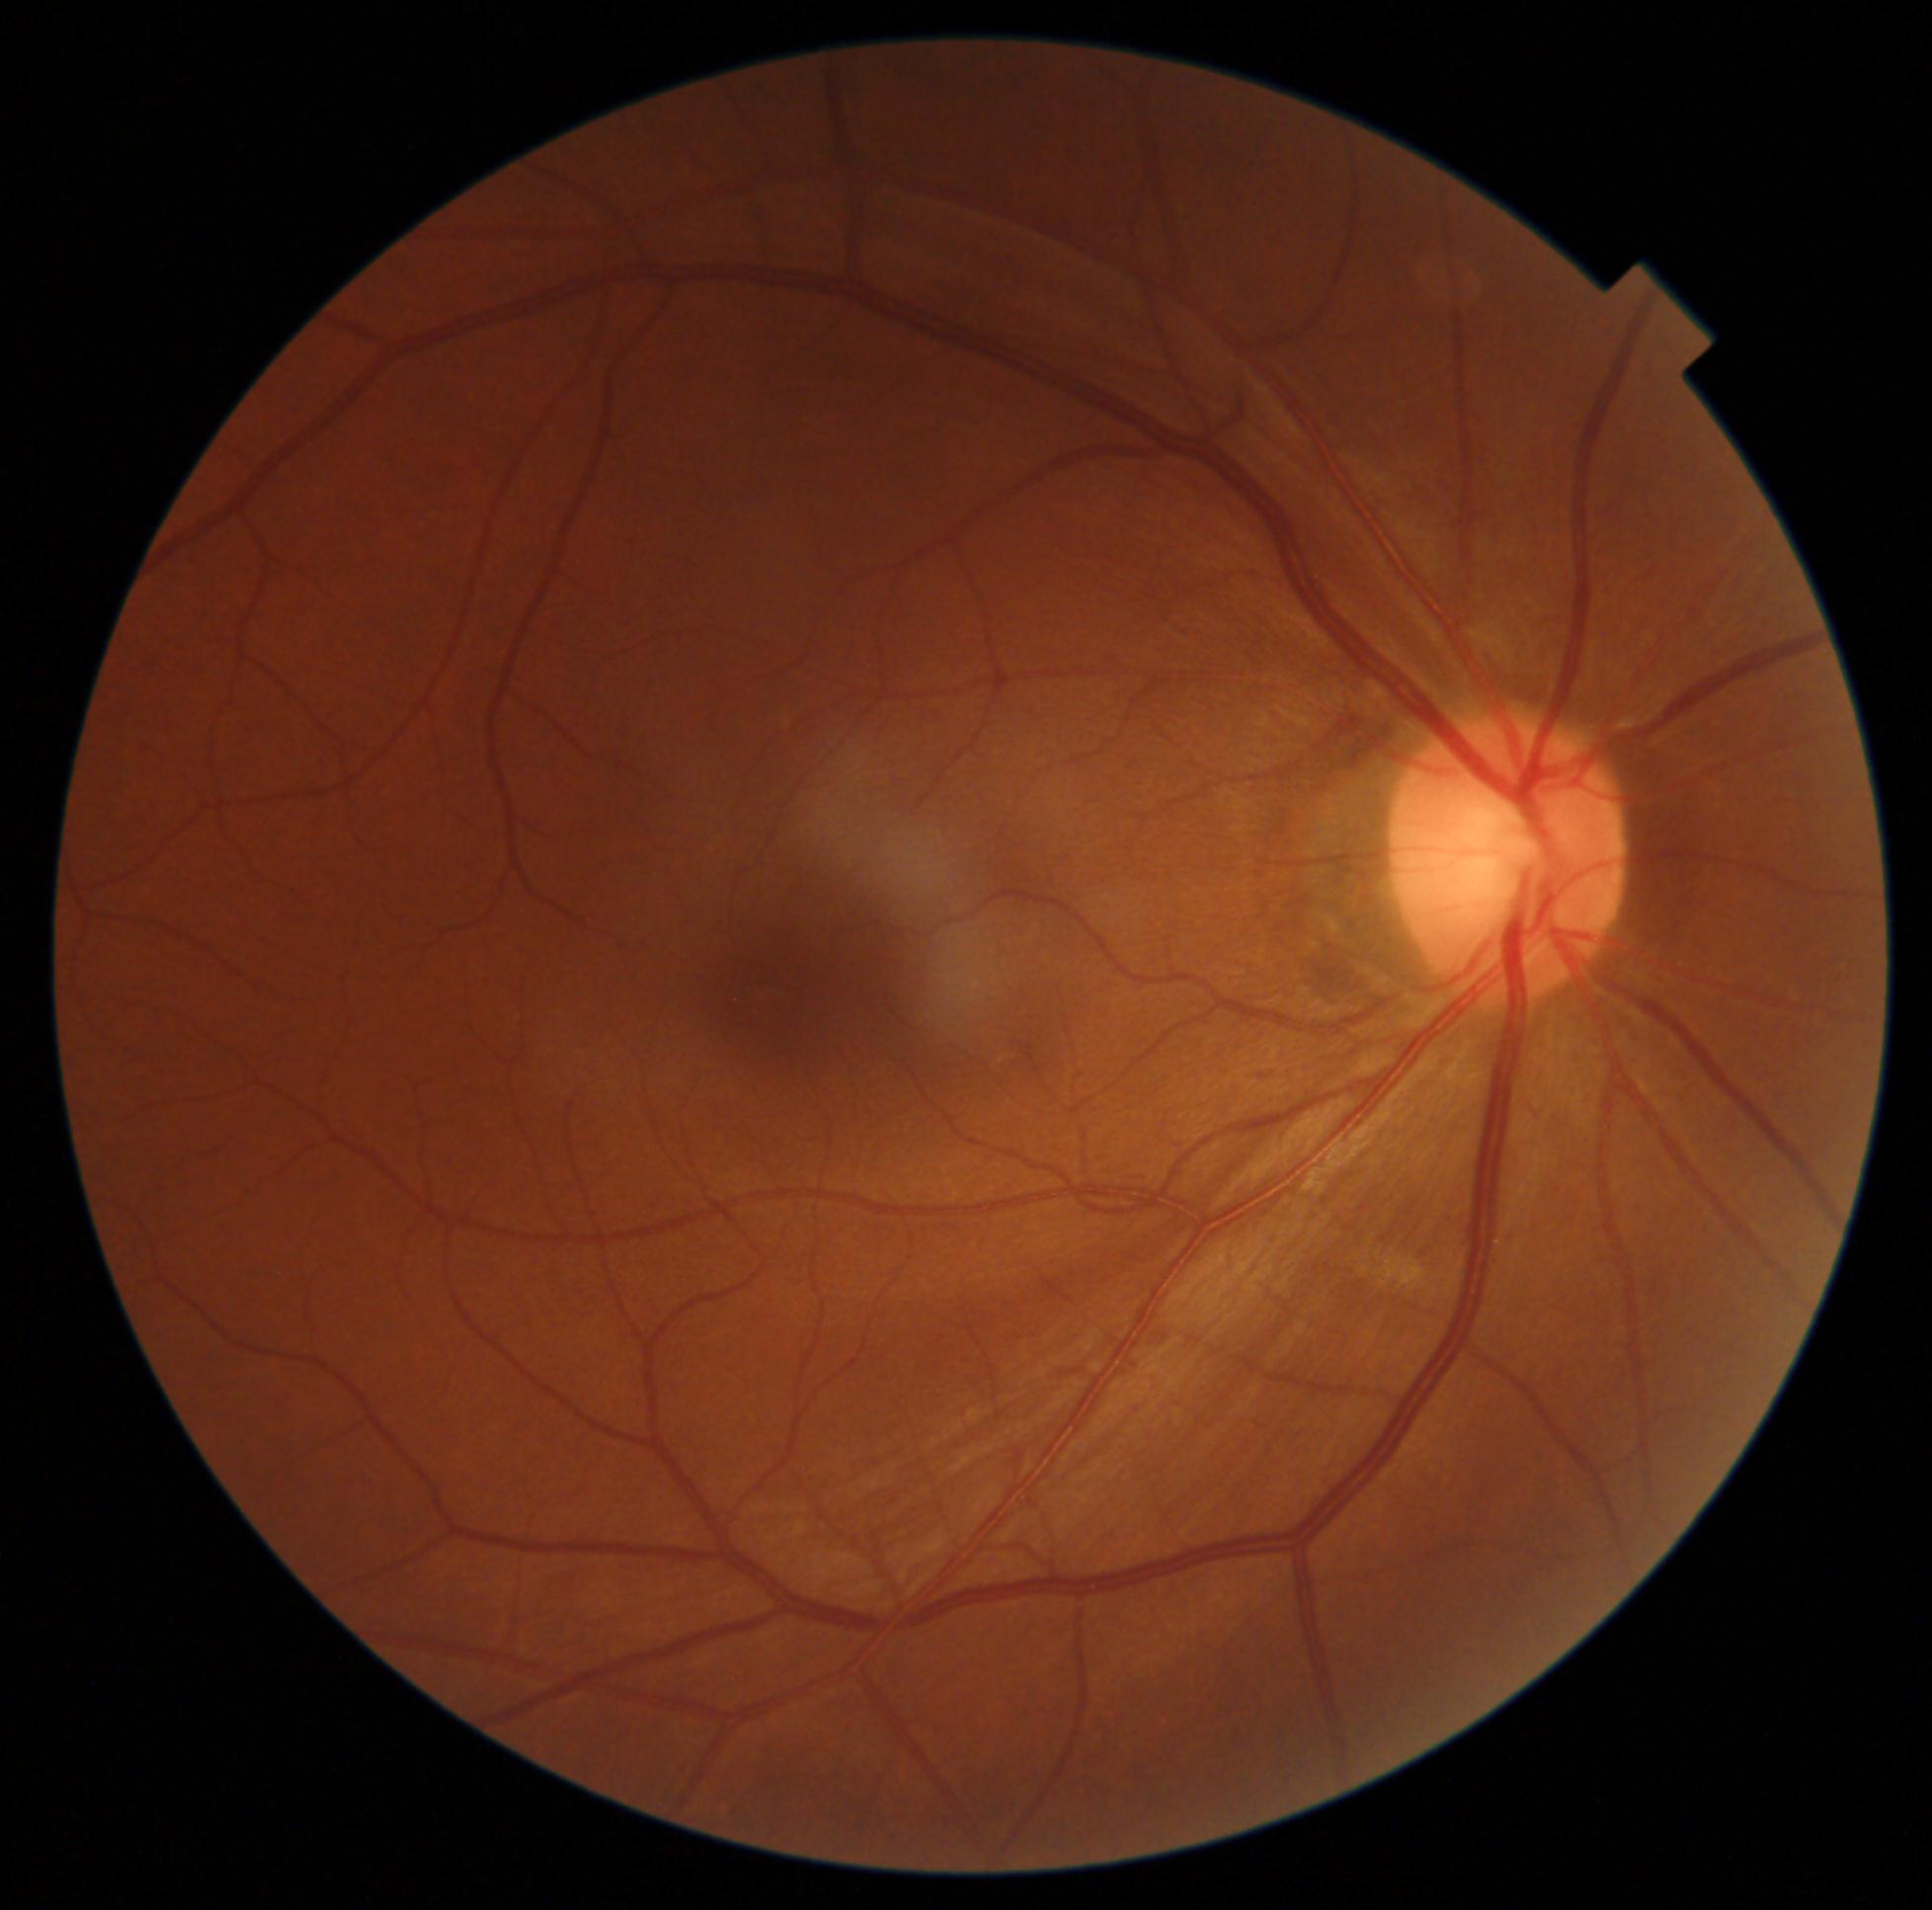 - DR impression — no apparent DR
- diabetic retinopathy (DR) — 0/4